200-degree field of view. 1924x1556px. Ultra-widefield fundus photograph
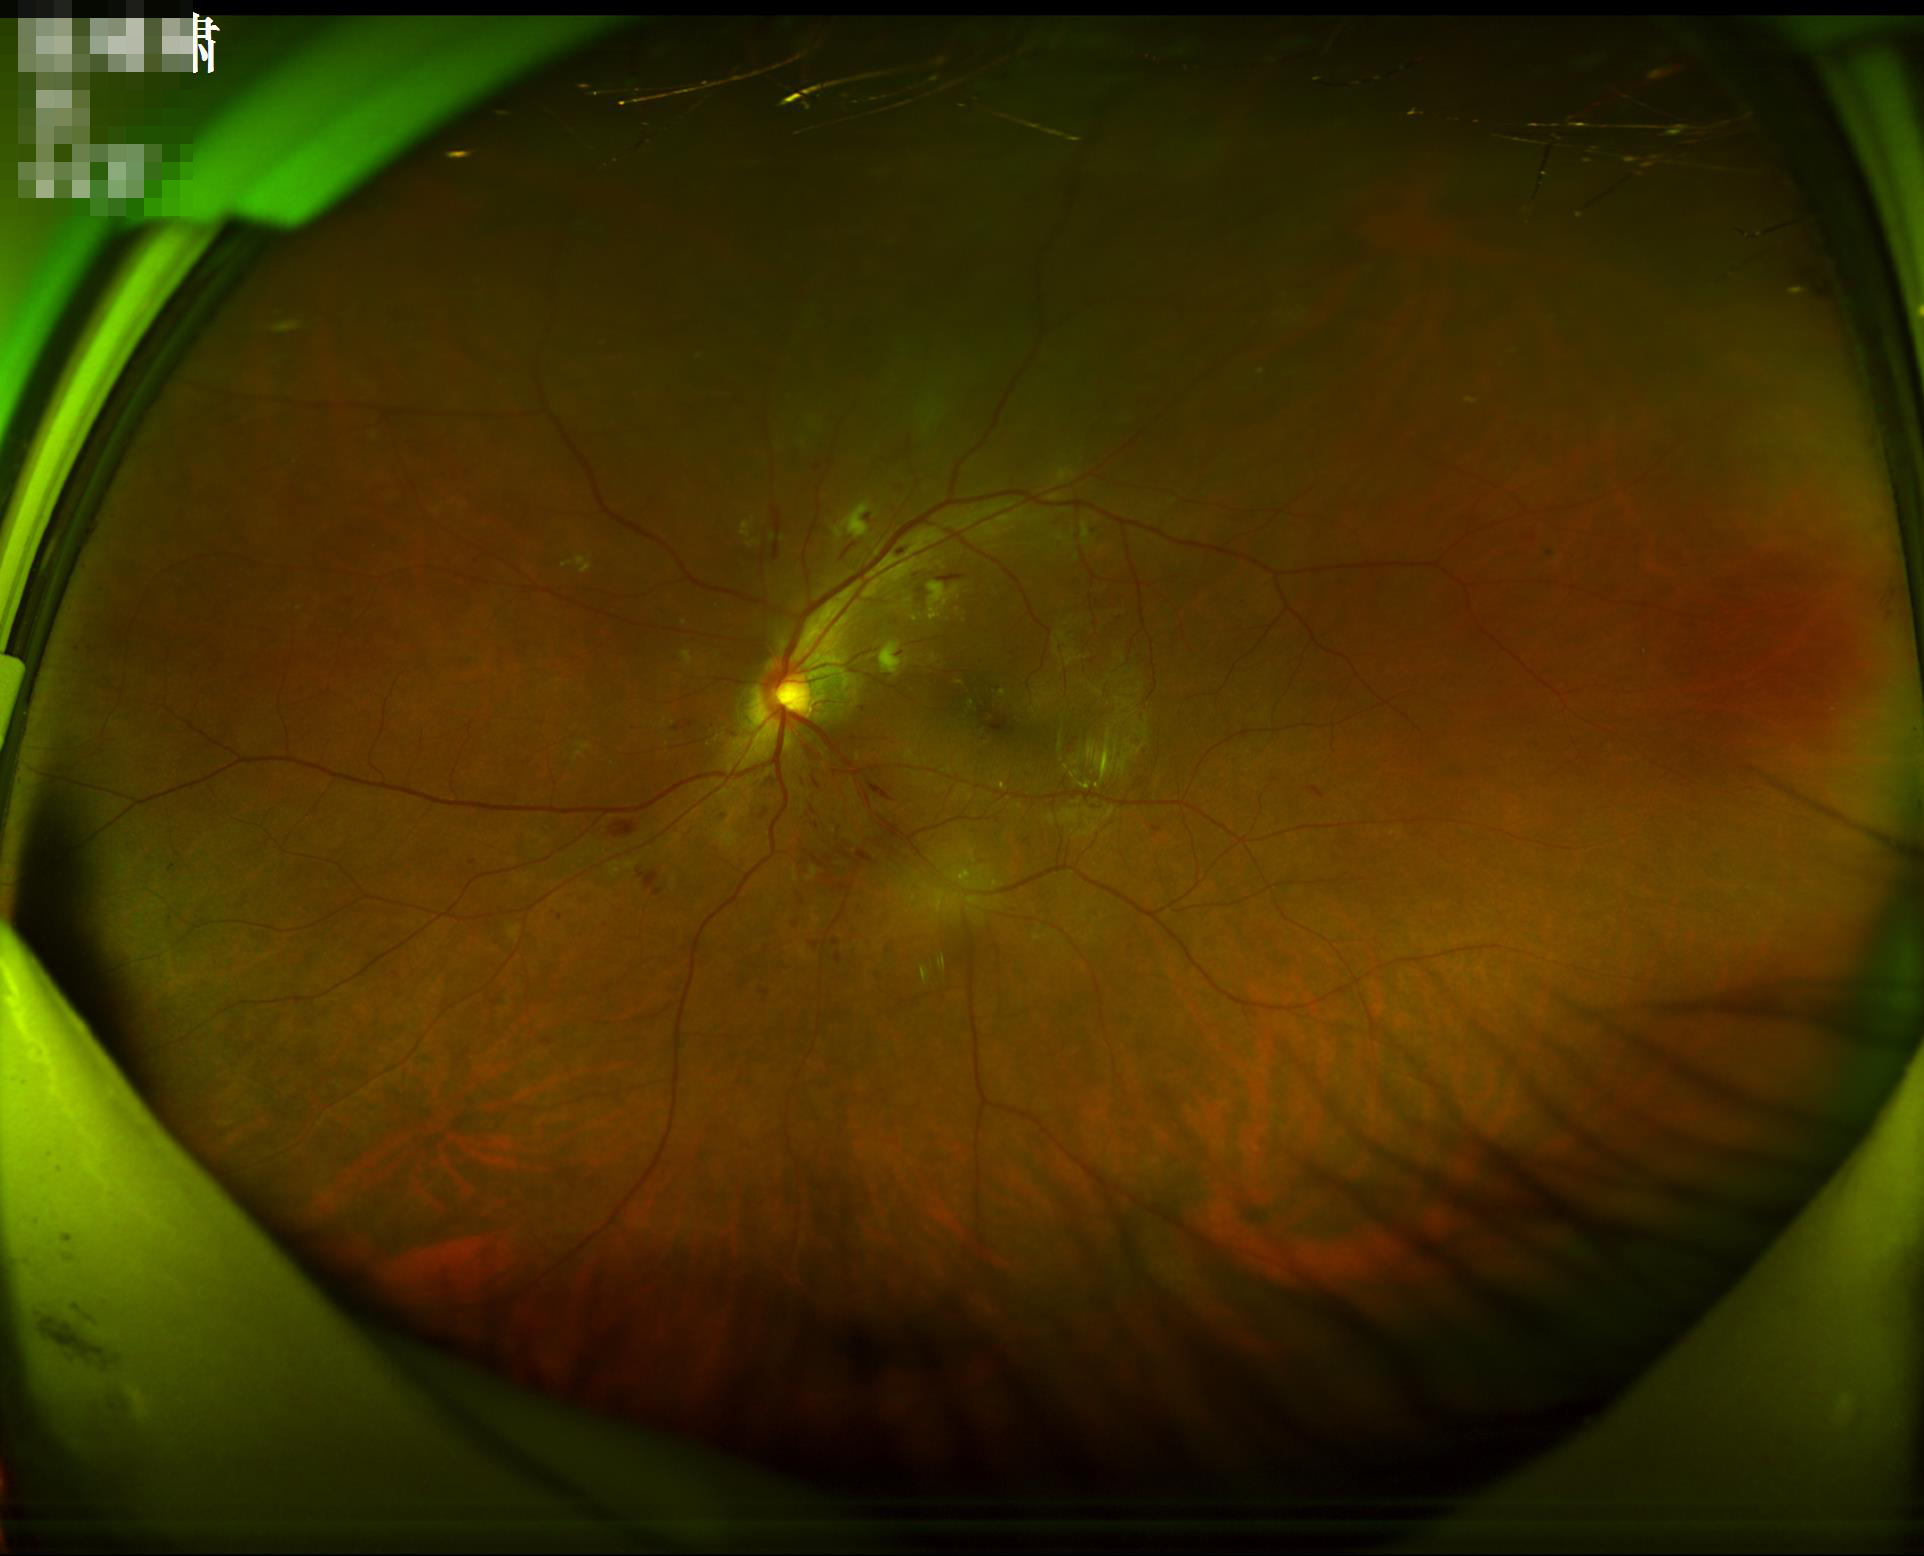 Optic disc, vessels, and background are in focus.
Vessels and details are readily distinguishable.
Overall quality is good and the image is gradable.
Even illumination with no color cast.